Fundus photograph cropped around the optic nerve head · image size 385x385:
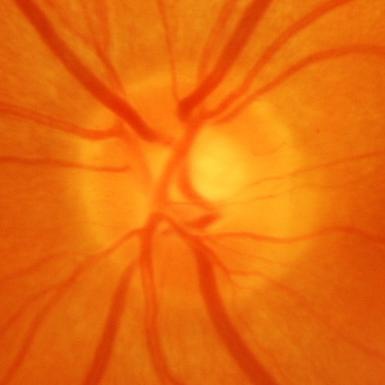 Glaucomatous optic neuropathy is present. Optic disc appearance consistent with glaucomatous changes.